Disc-centered field; 240x240px; retinal fundus photograph: 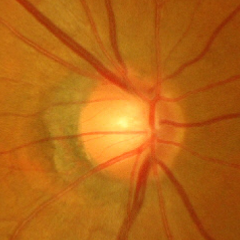

Q: Is glaucoma present?
A: Severe glaucomatous damage.